Modified Davis grading.
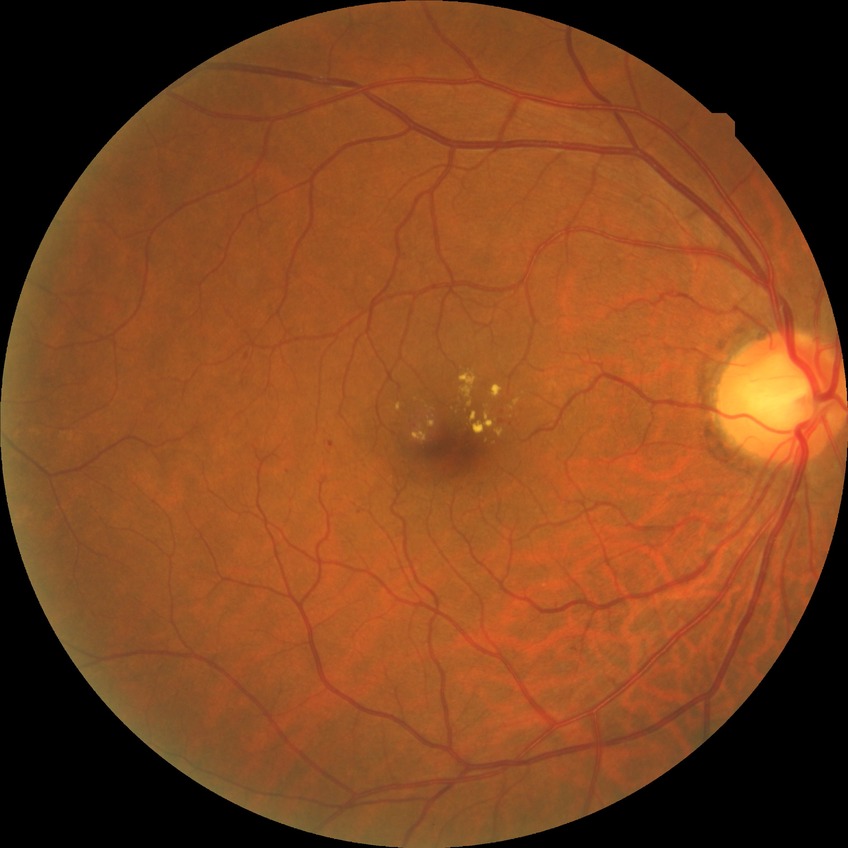
DR class: non-proliferative diabetic retinopathy.
Diabetic retinopathy (DR): SDR (simple diabetic retinopathy).